Wide-field fundus photograph from neonatal ROP screening; image size 1240x1240.
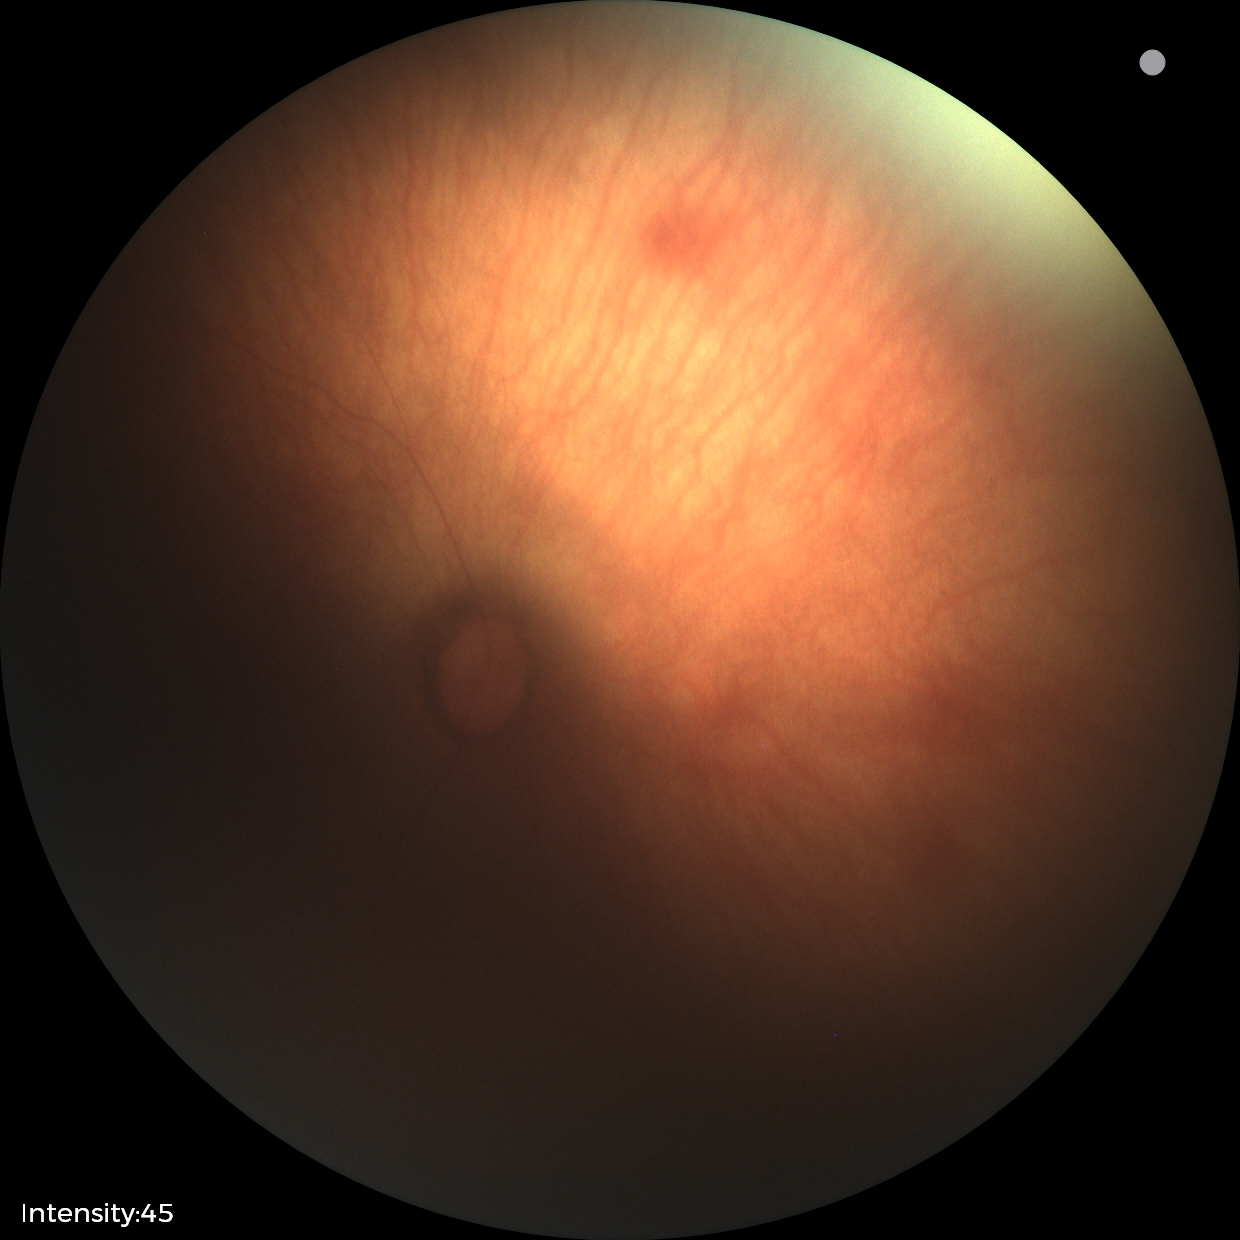
Examination with physiological retinal findings.